Pediatric retinal photograph (wide-field).
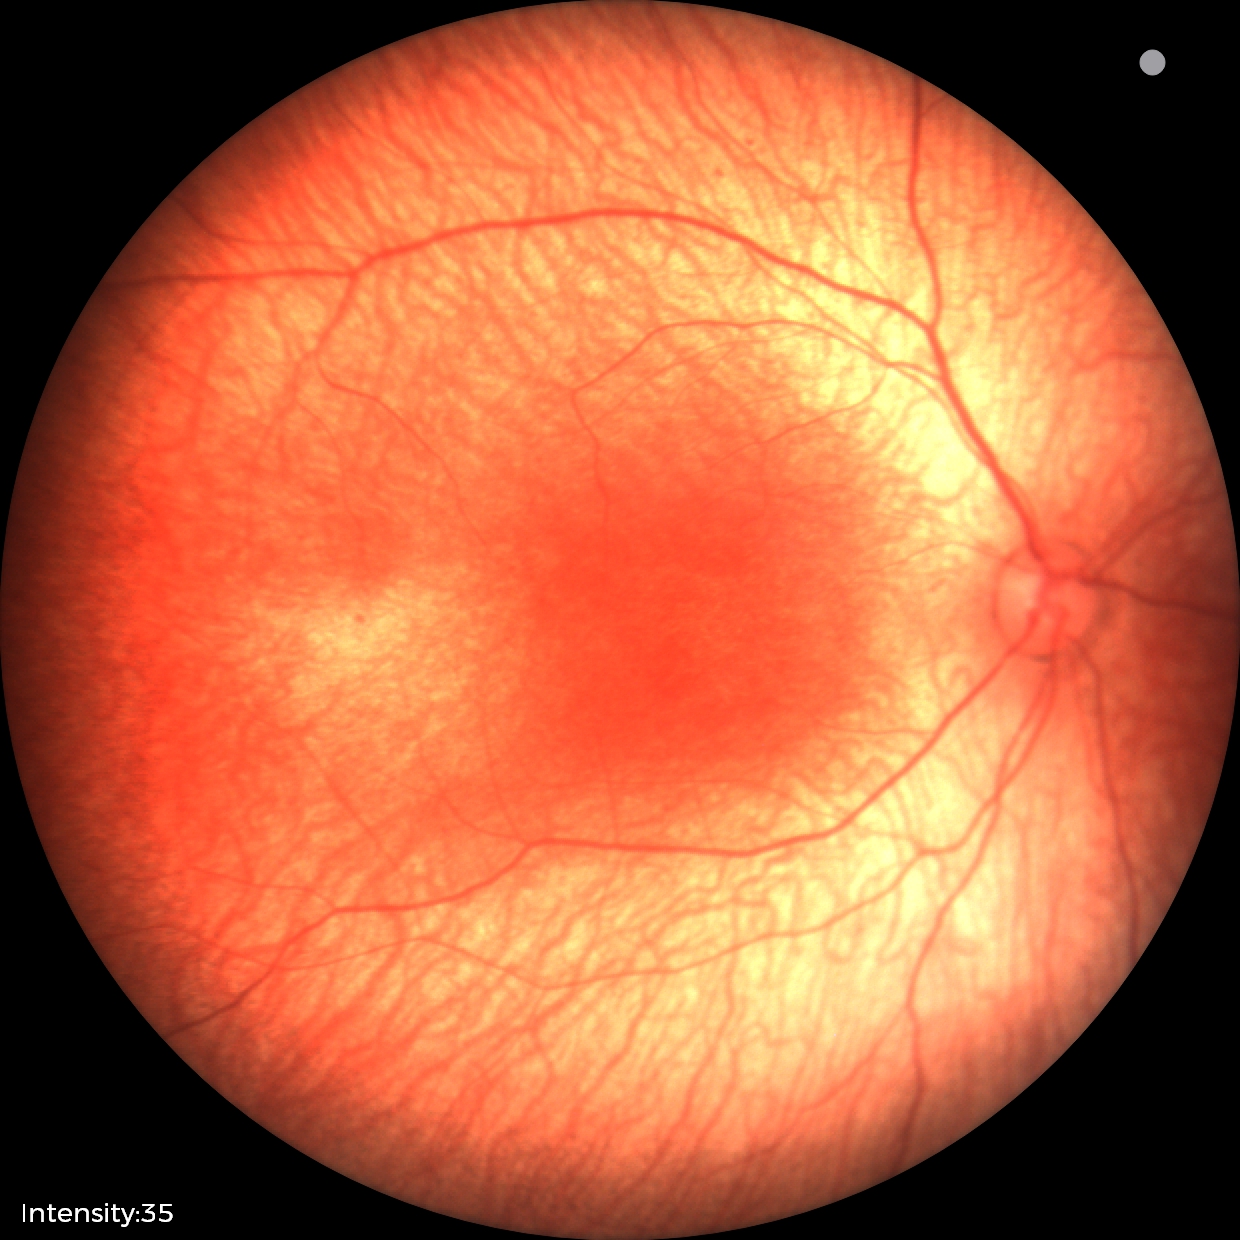 Normal screening examination.